Pachymetry: 592 µm · axial length (AL) 24 mm · patient age: 48 years.
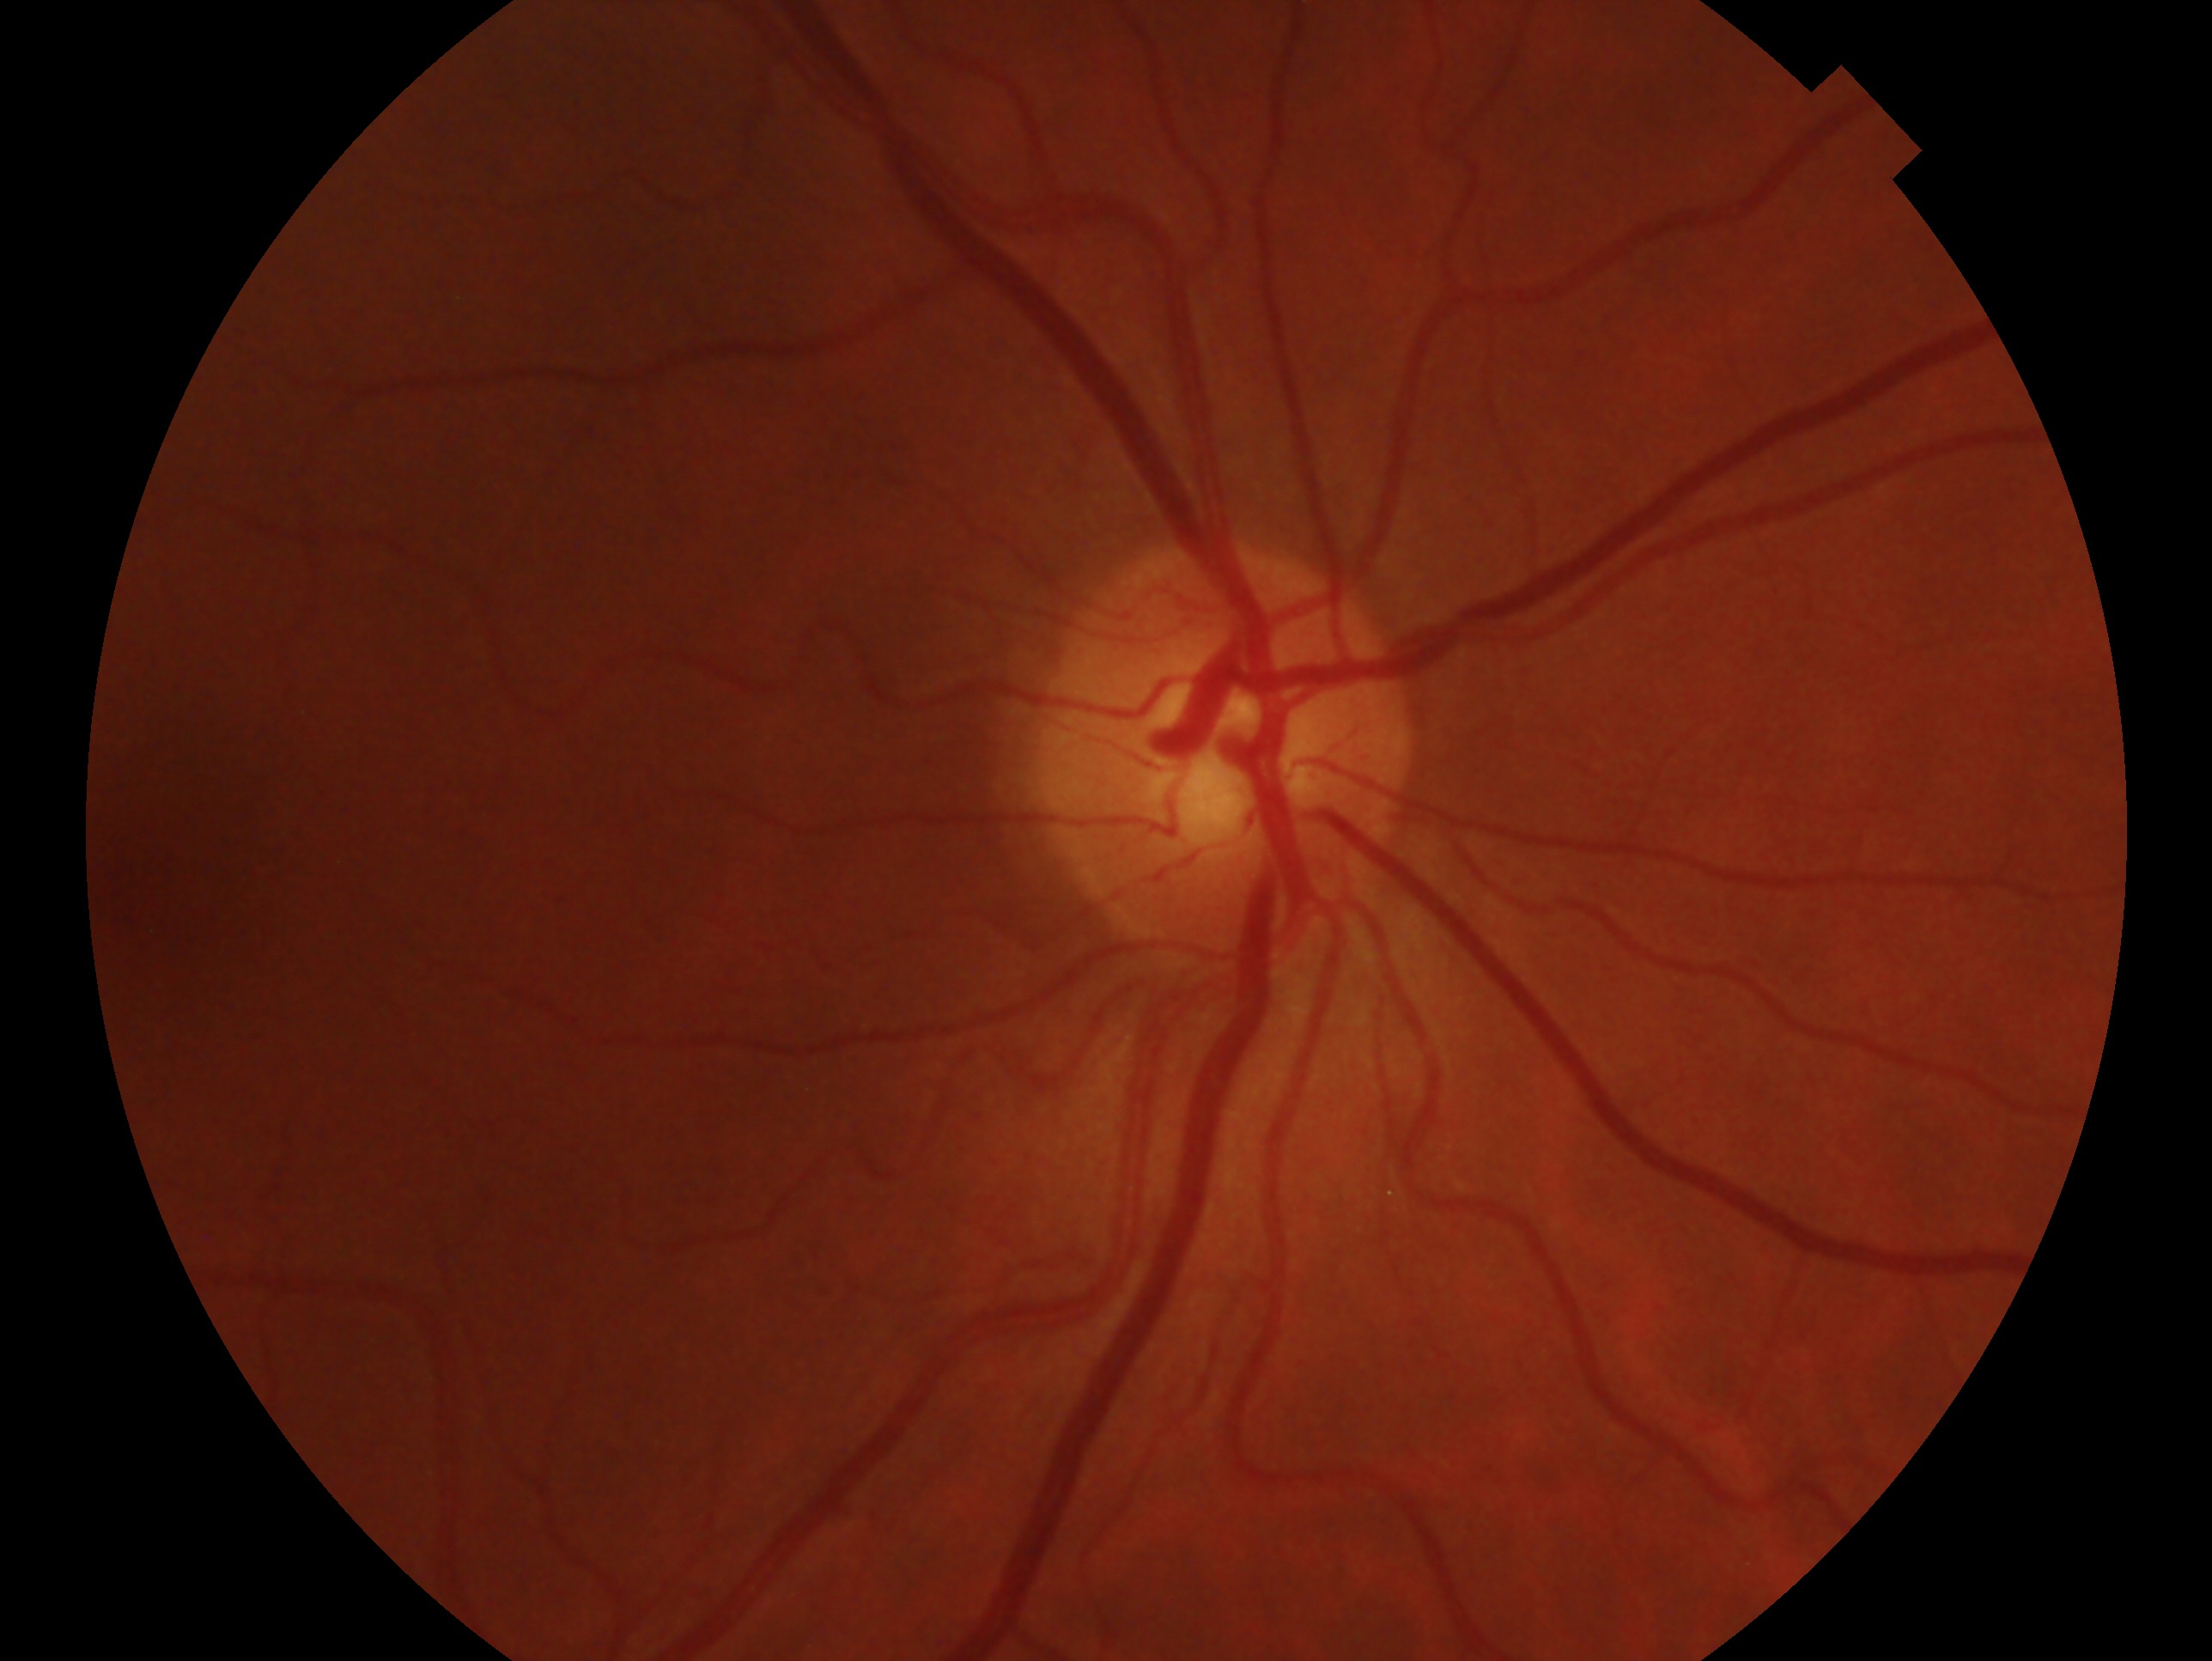
Eye: right. Assessment: no evidence of glaucoma.